Acquired with a Remidio Fundus on Phone.
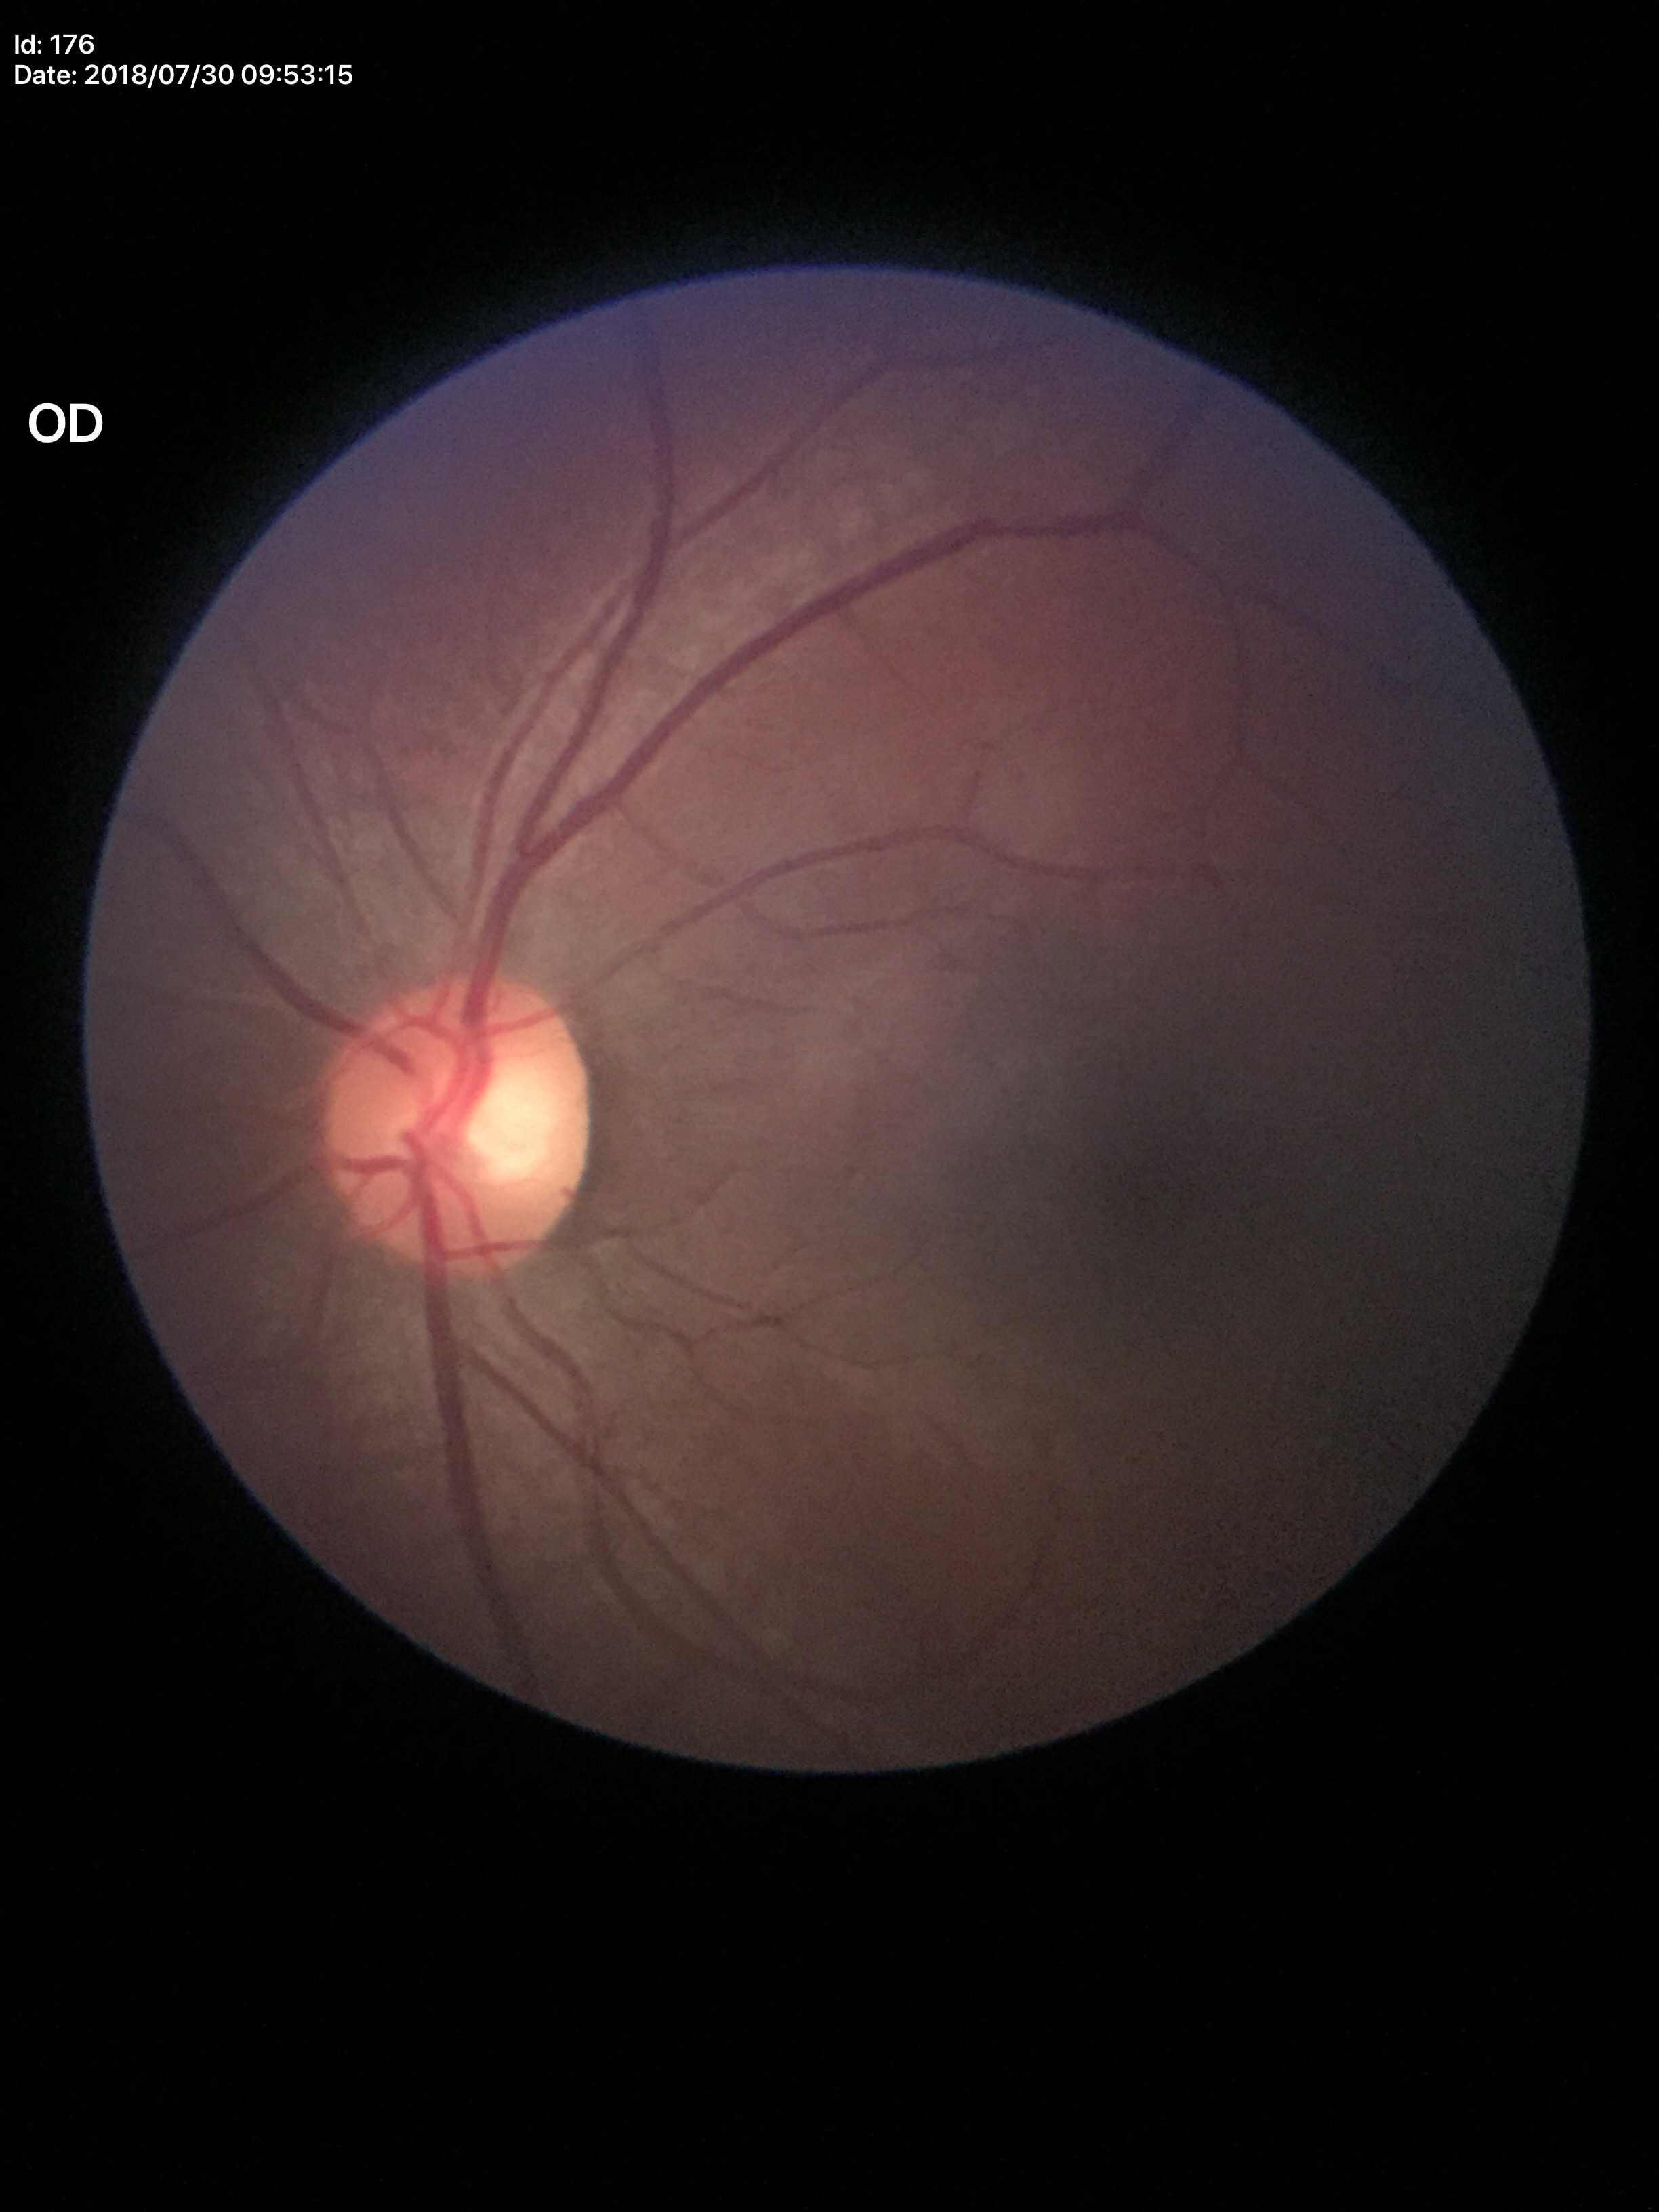

Glaucoma screening: no suspicious findings
area C/D ratio (ACDR): 0.32
vertical CDR (VCDR): 0.53